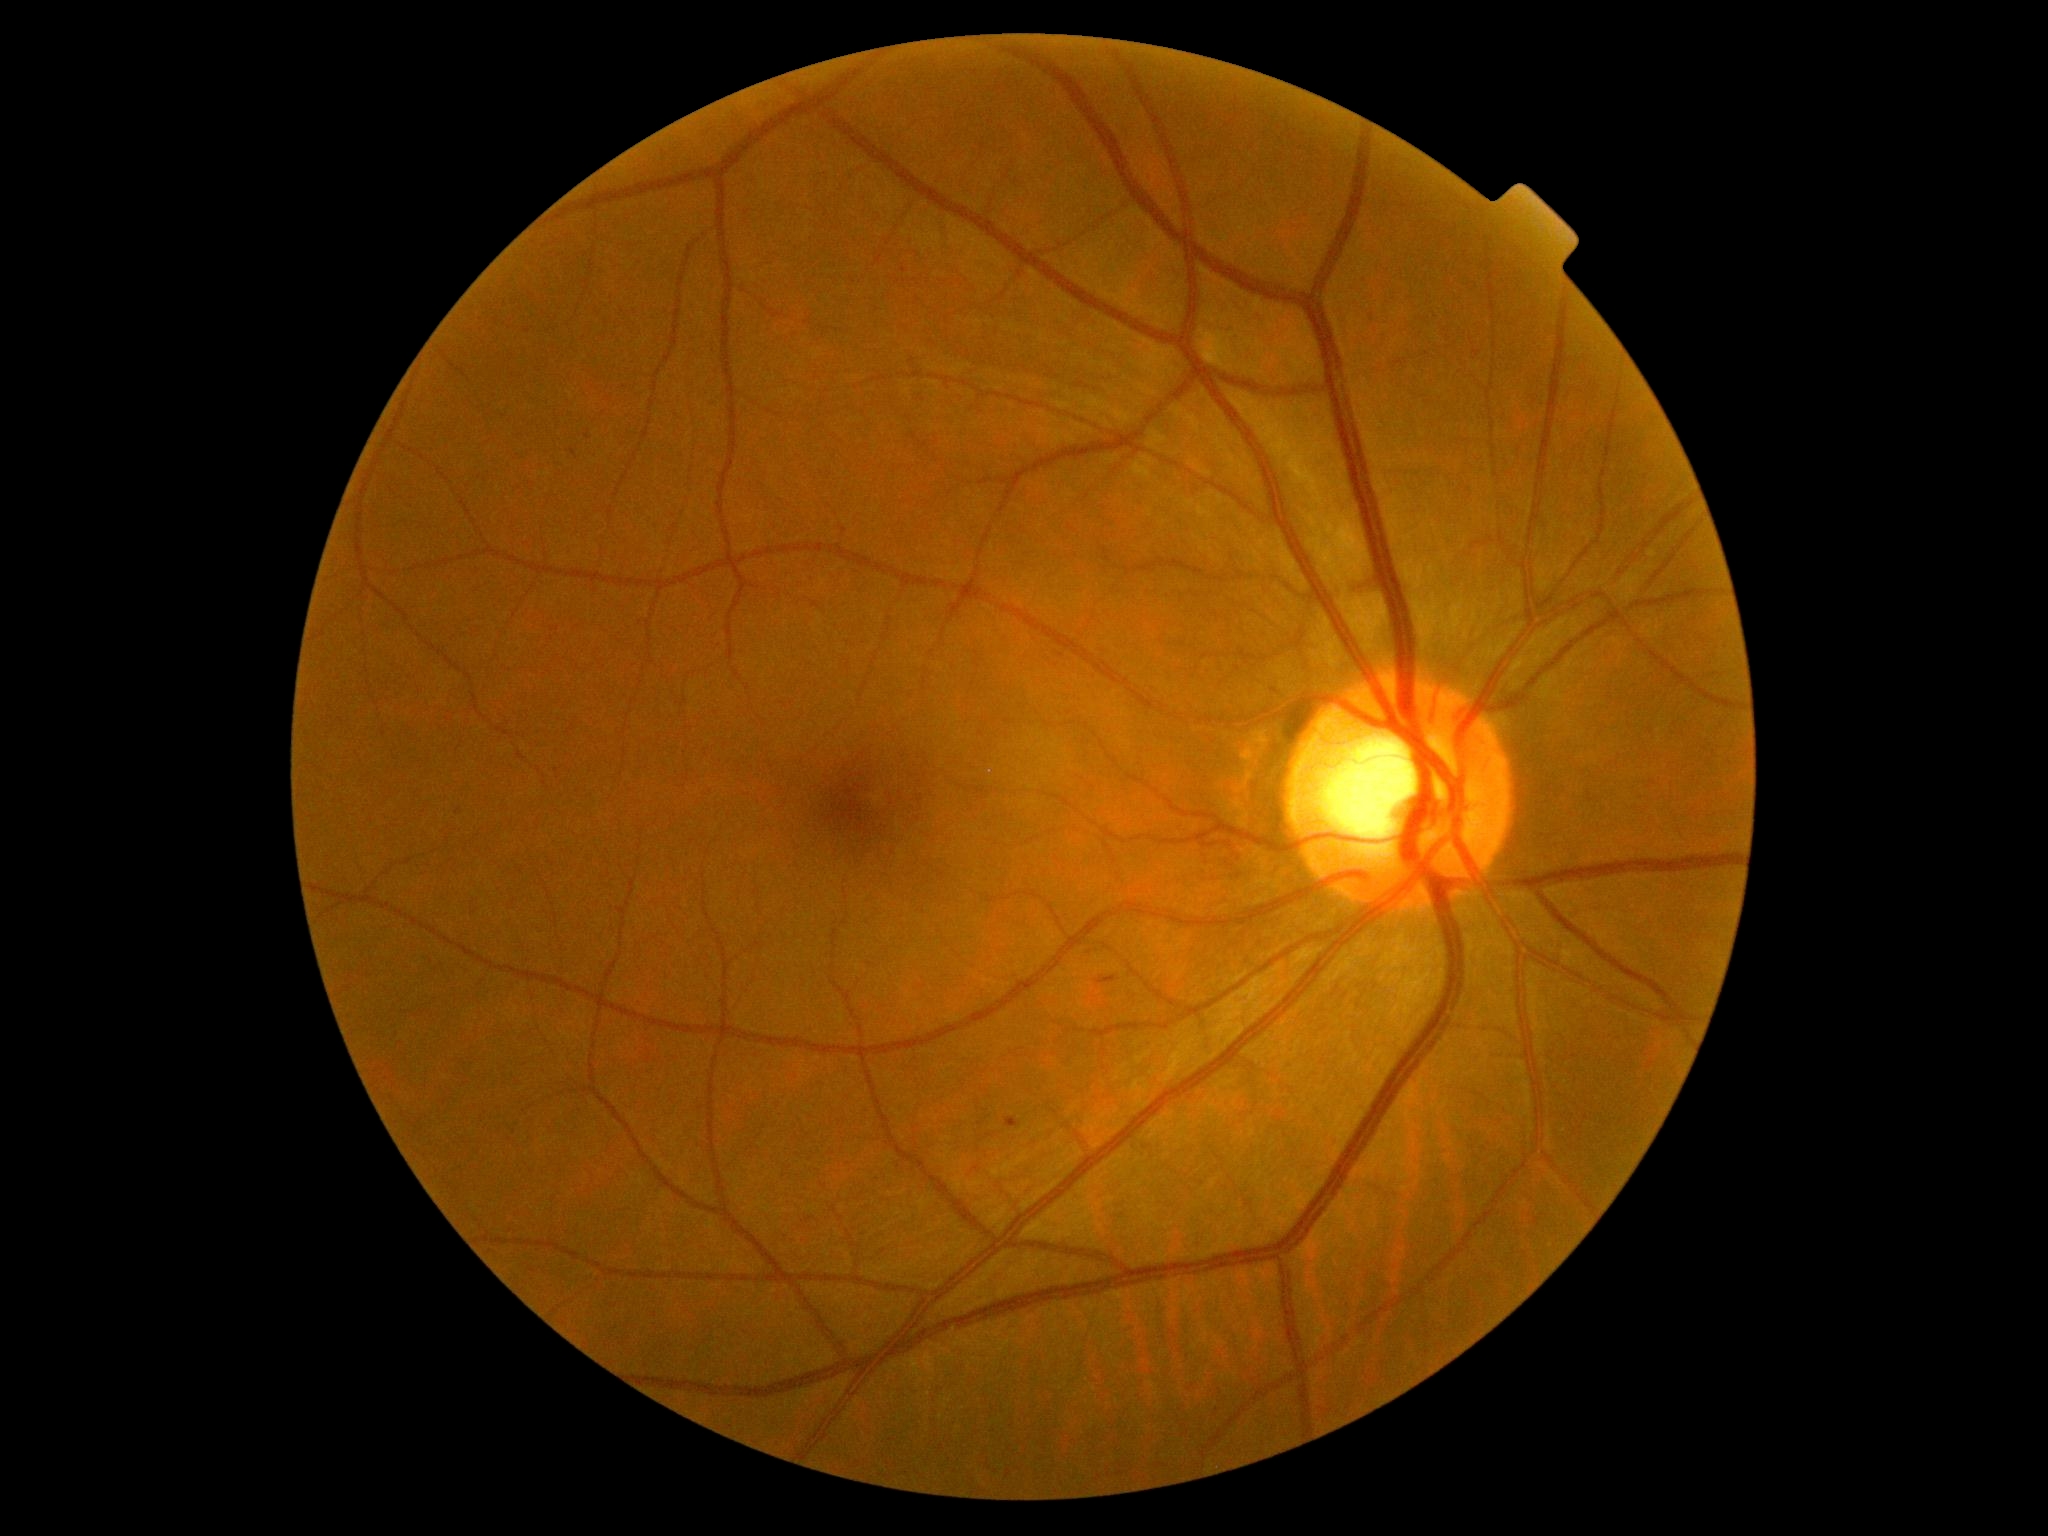 – diabetic retinopathy (DR) — grade 2 (moderate NPDR) — more than just microaneurysms but less than severe NPDR